Image size 512x512: 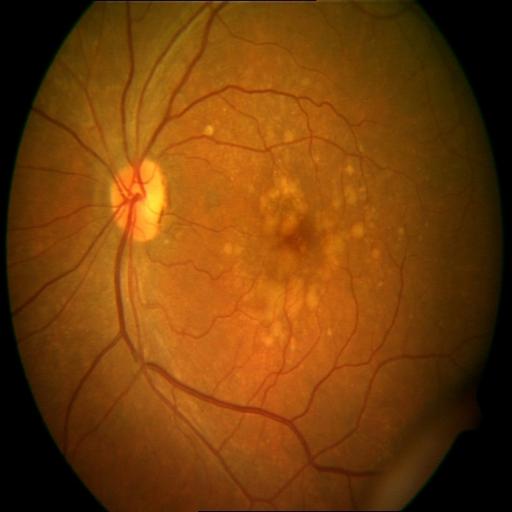 Findings consistent with drusen.